Pediatric wide-field fundus photograph:
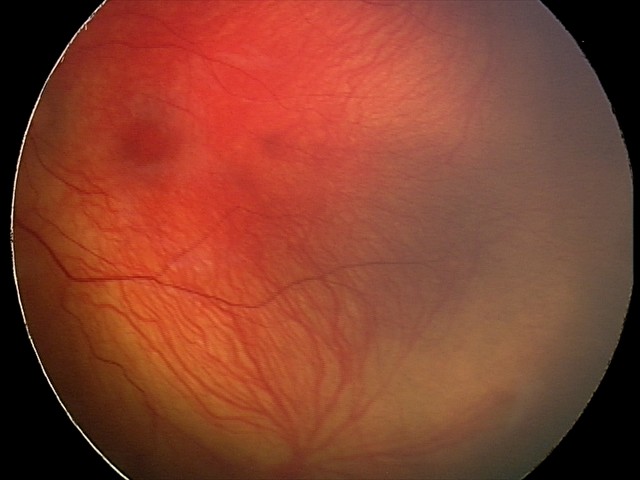 Plus disease absent. Screening examination consistent with status post retinopathy of prematurity — retinal appearance after treated retinopathy of prematurity.